Color fundus photograph · centered on the optic disc · captured without pupil dilation — 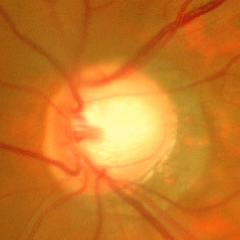
Advanced glaucomatous optic neuropathy.